Diabetic retinopathy graded by the modified Davis classification. 848 by 848 pixels. Camera: NIDEK AFC-230. No pharmacologic dilation. Posterior pole color fundus photograph
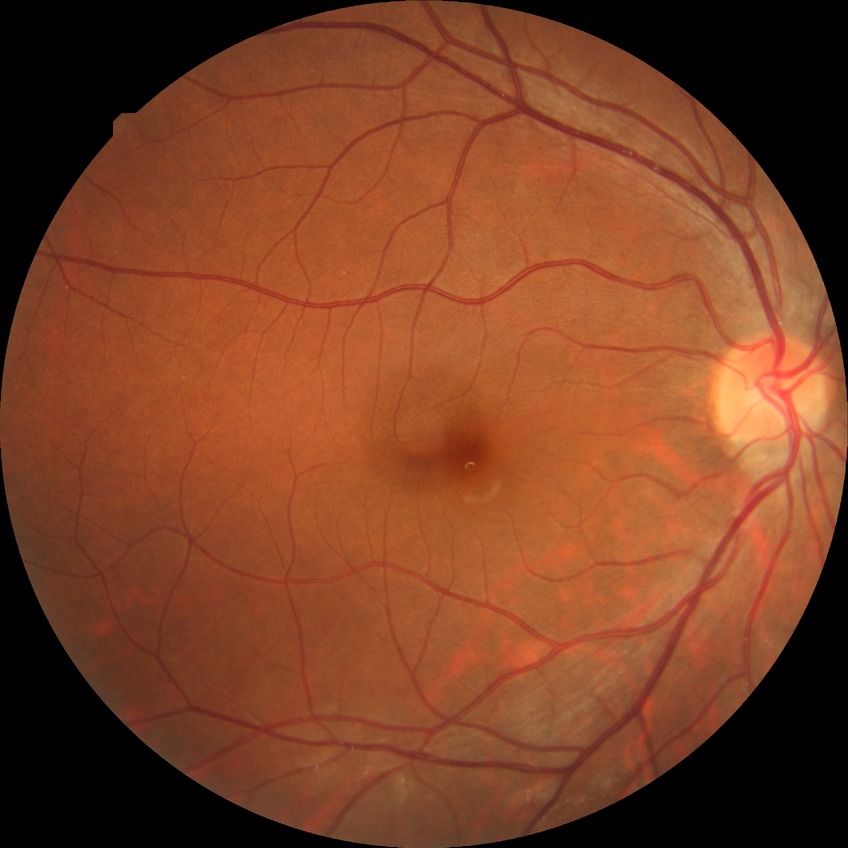 Diabetic retinopathy (DR) is NDR (no diabetic retinopathy).